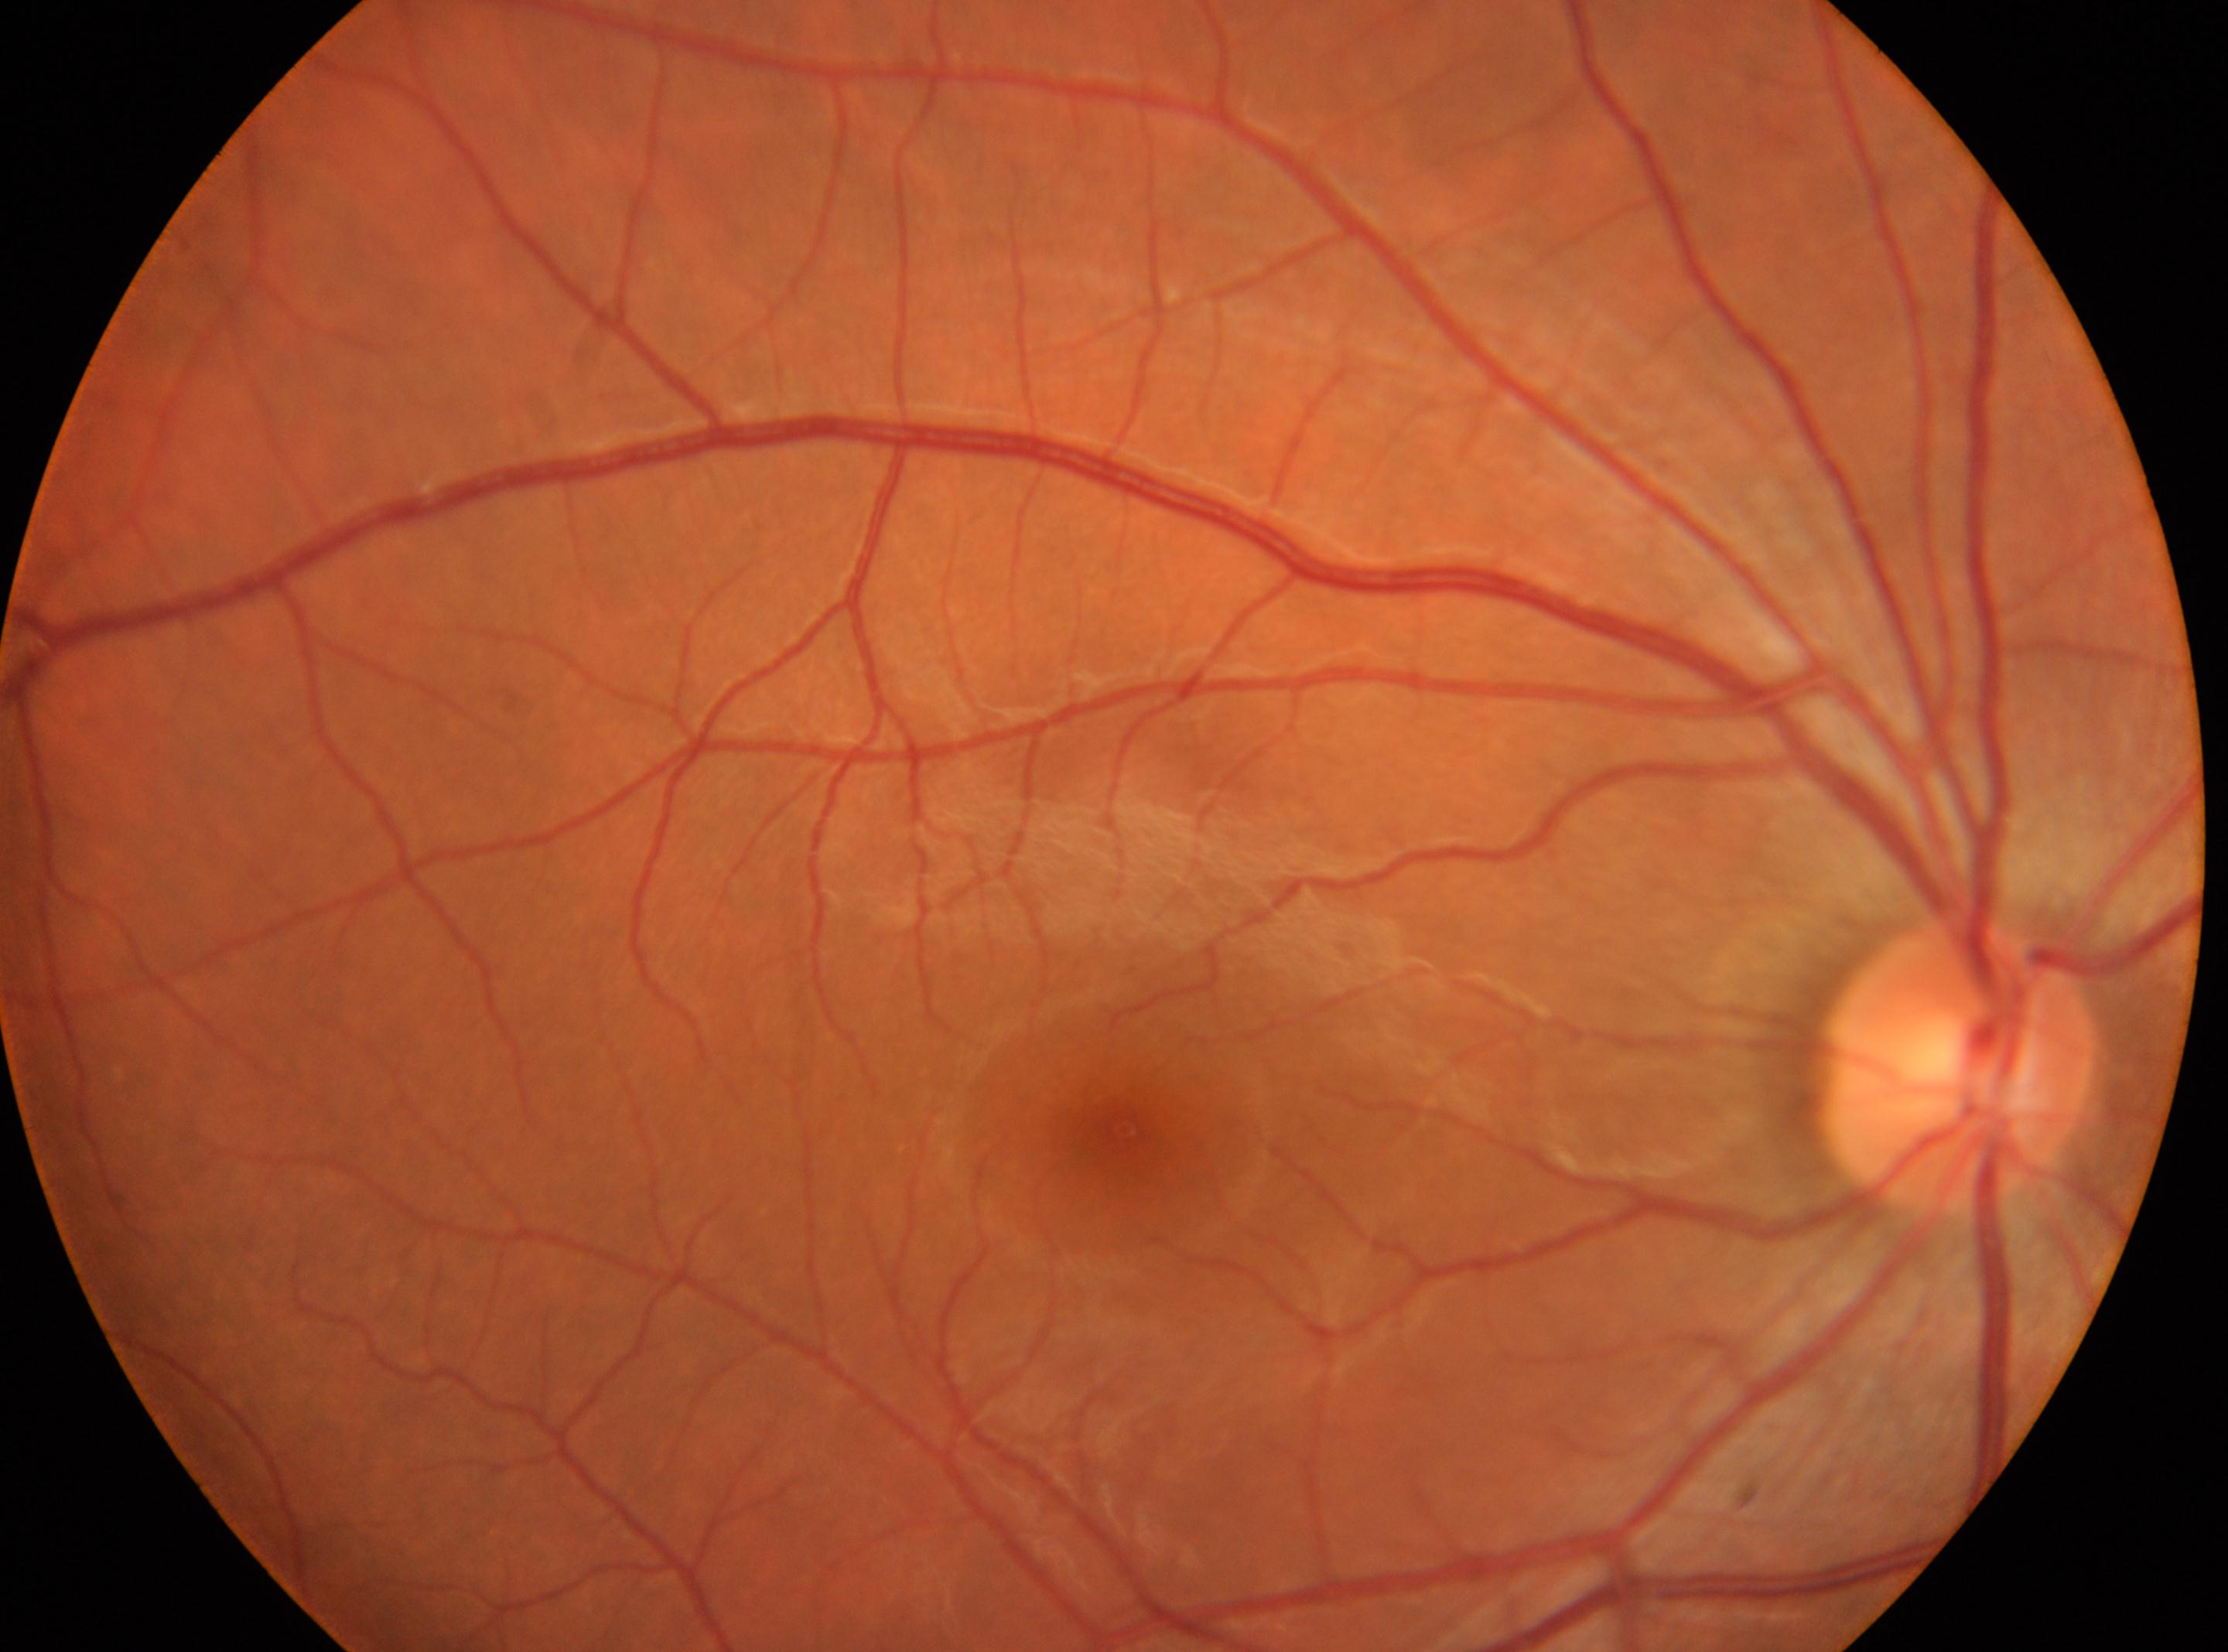
Annotations:
• laterality — the right eye
• macula center — (x=1123, y=1129)
• DR grade — no apparent diabetic retinopathy (0)
• optic disk — (x=1956, y=1063)